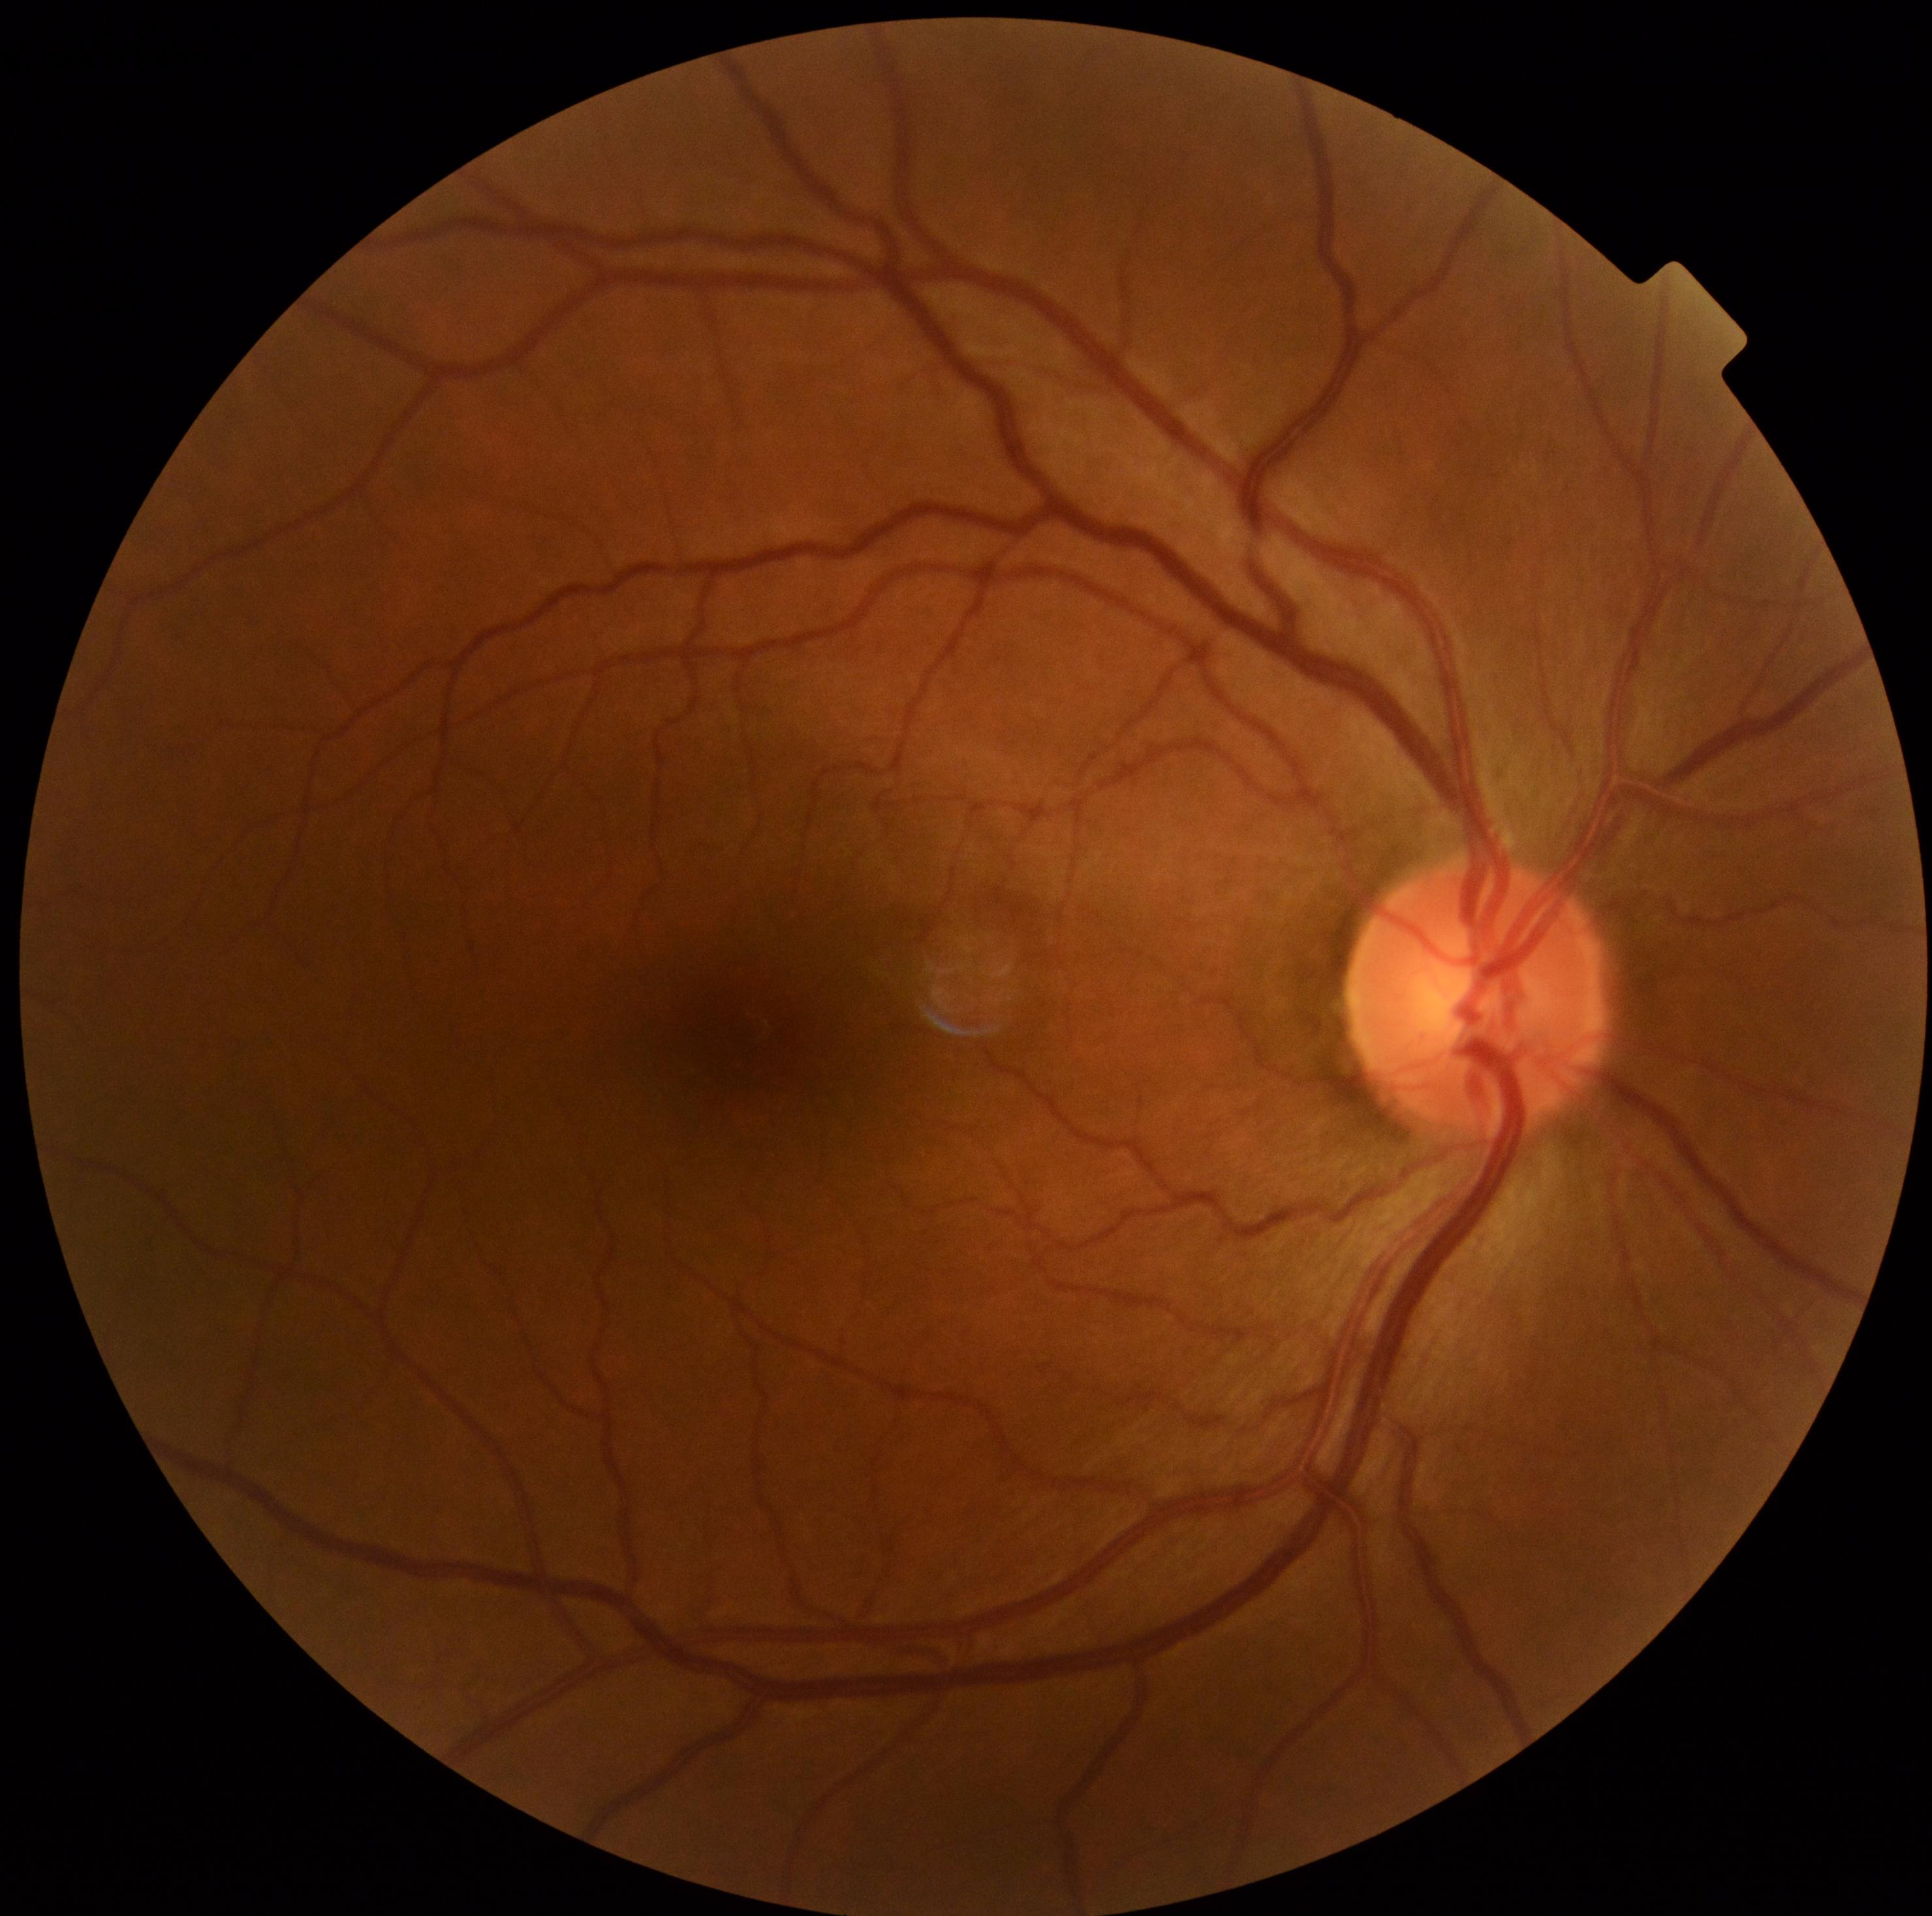 No apparent diabetic retinopathy.
DR is grade 0 (no apparent retinopathy).